45° field of view. Image size 2346x1568
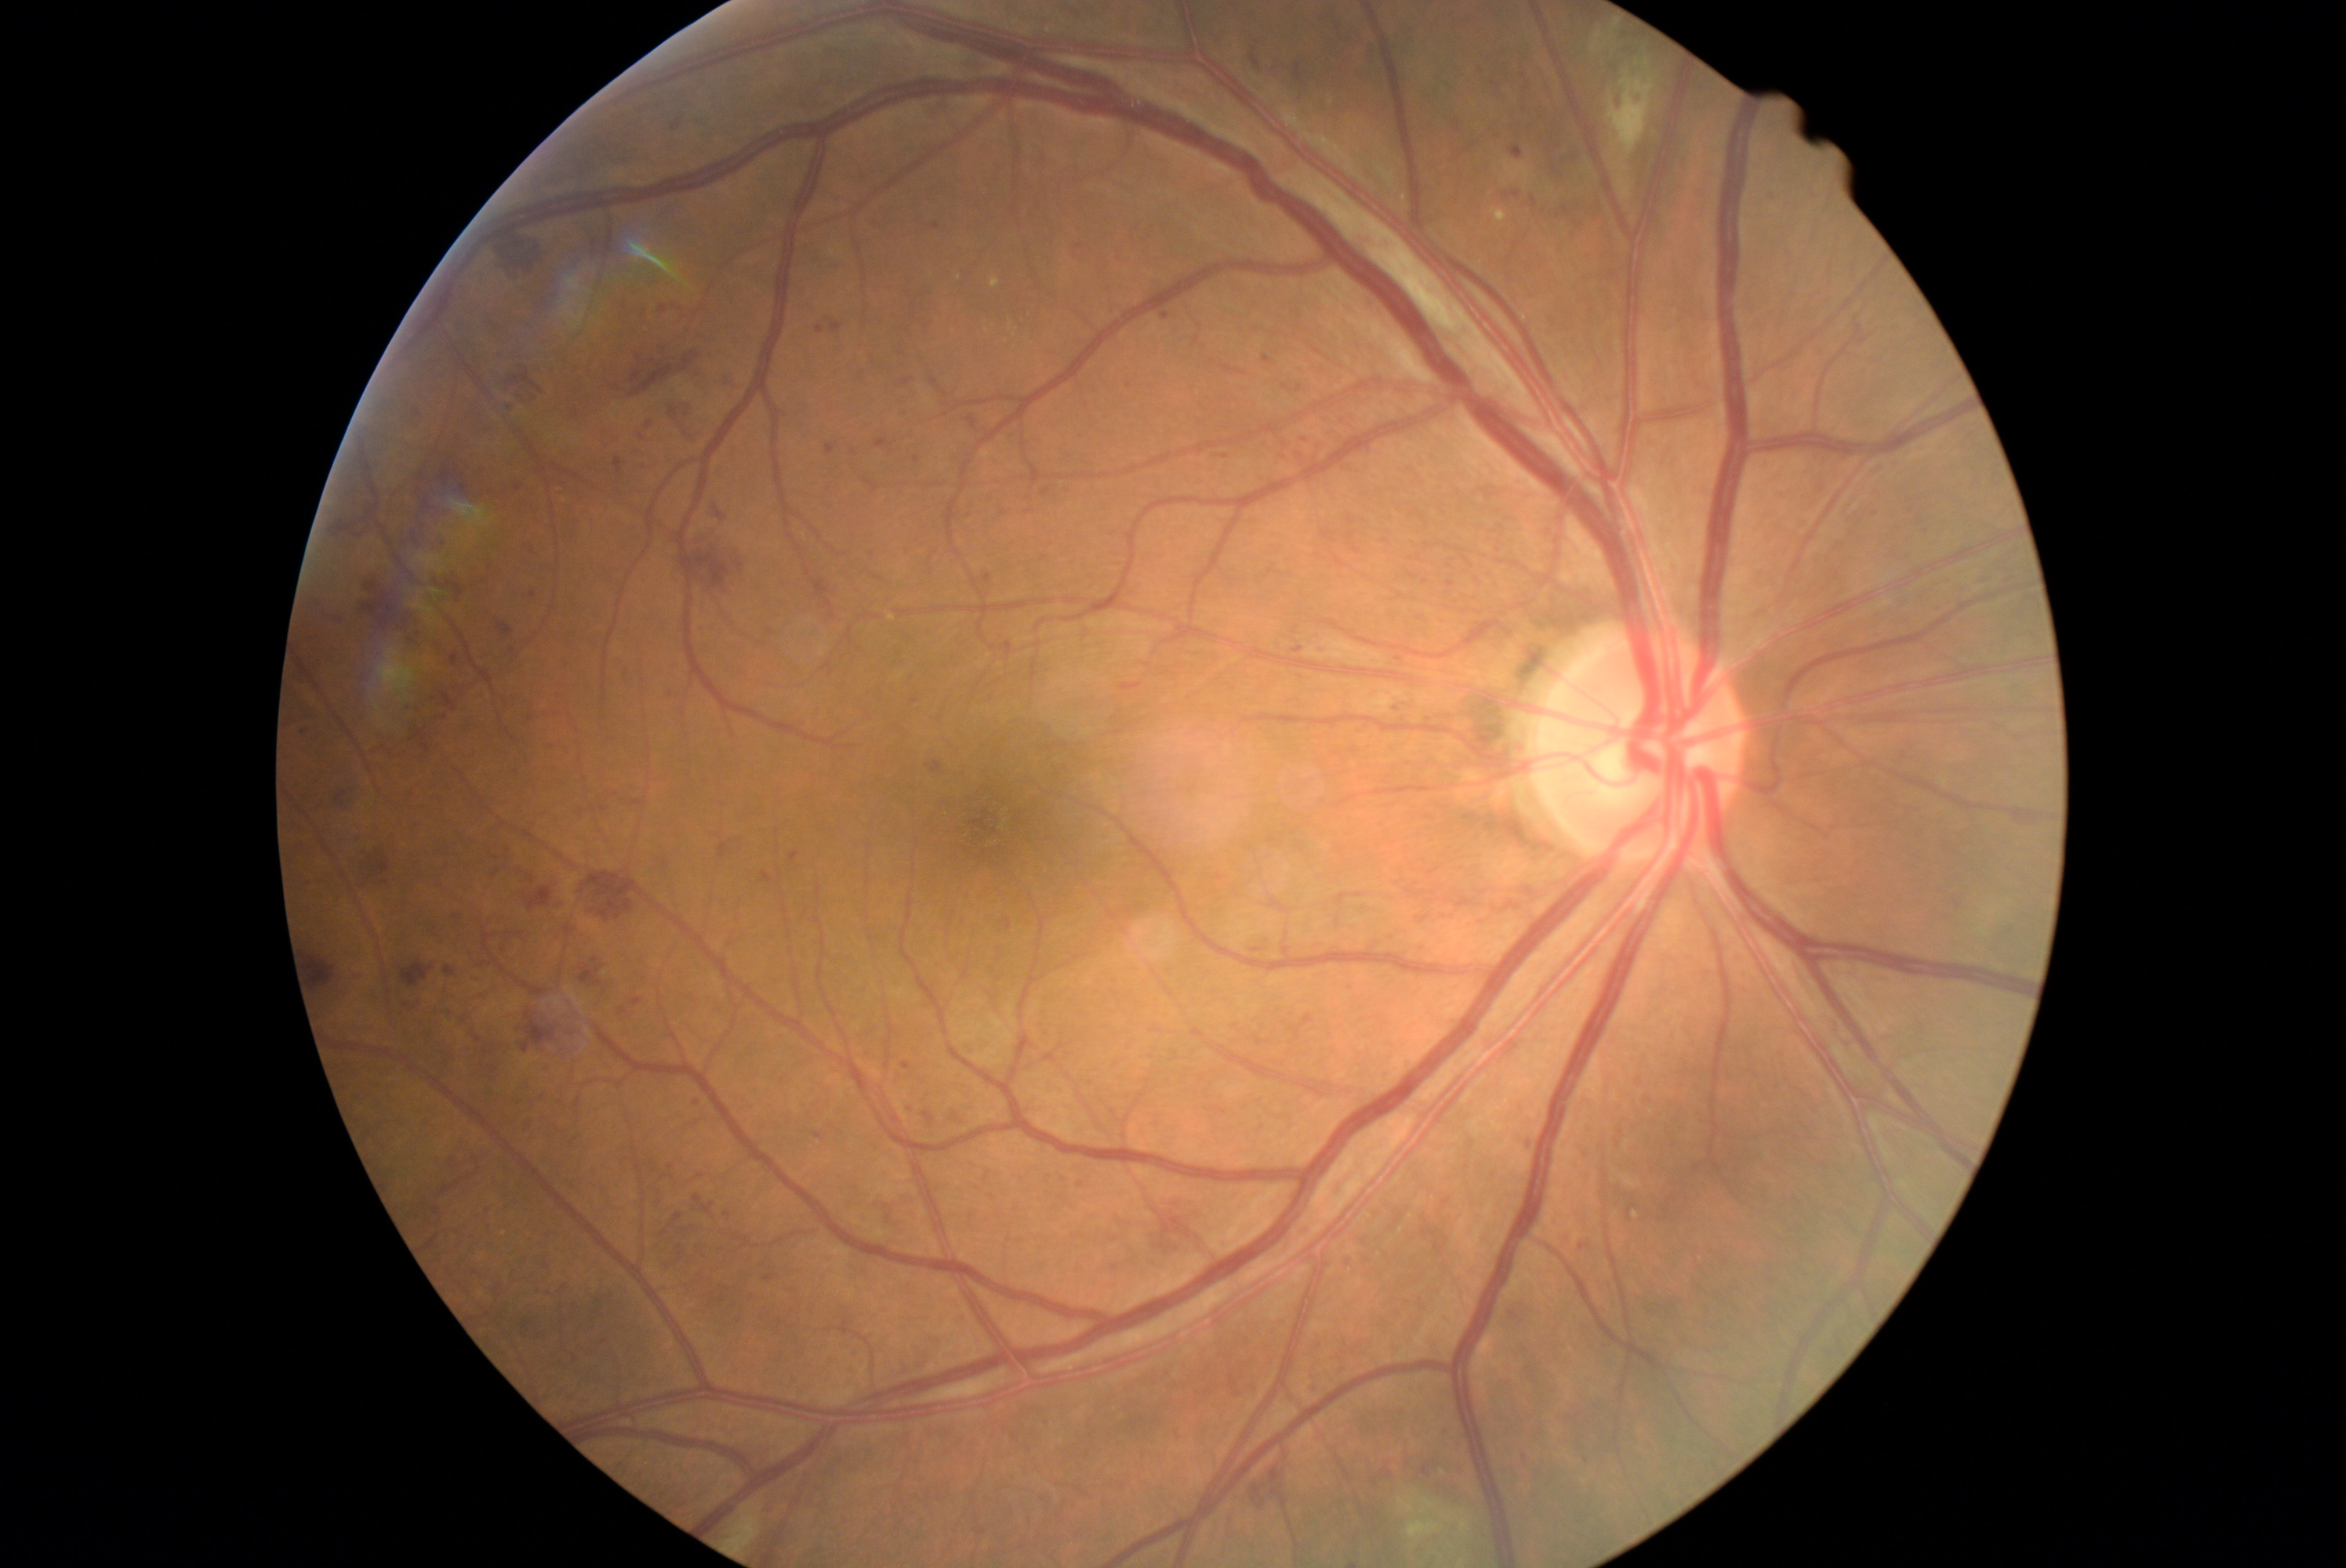 DR stage: grade 3.